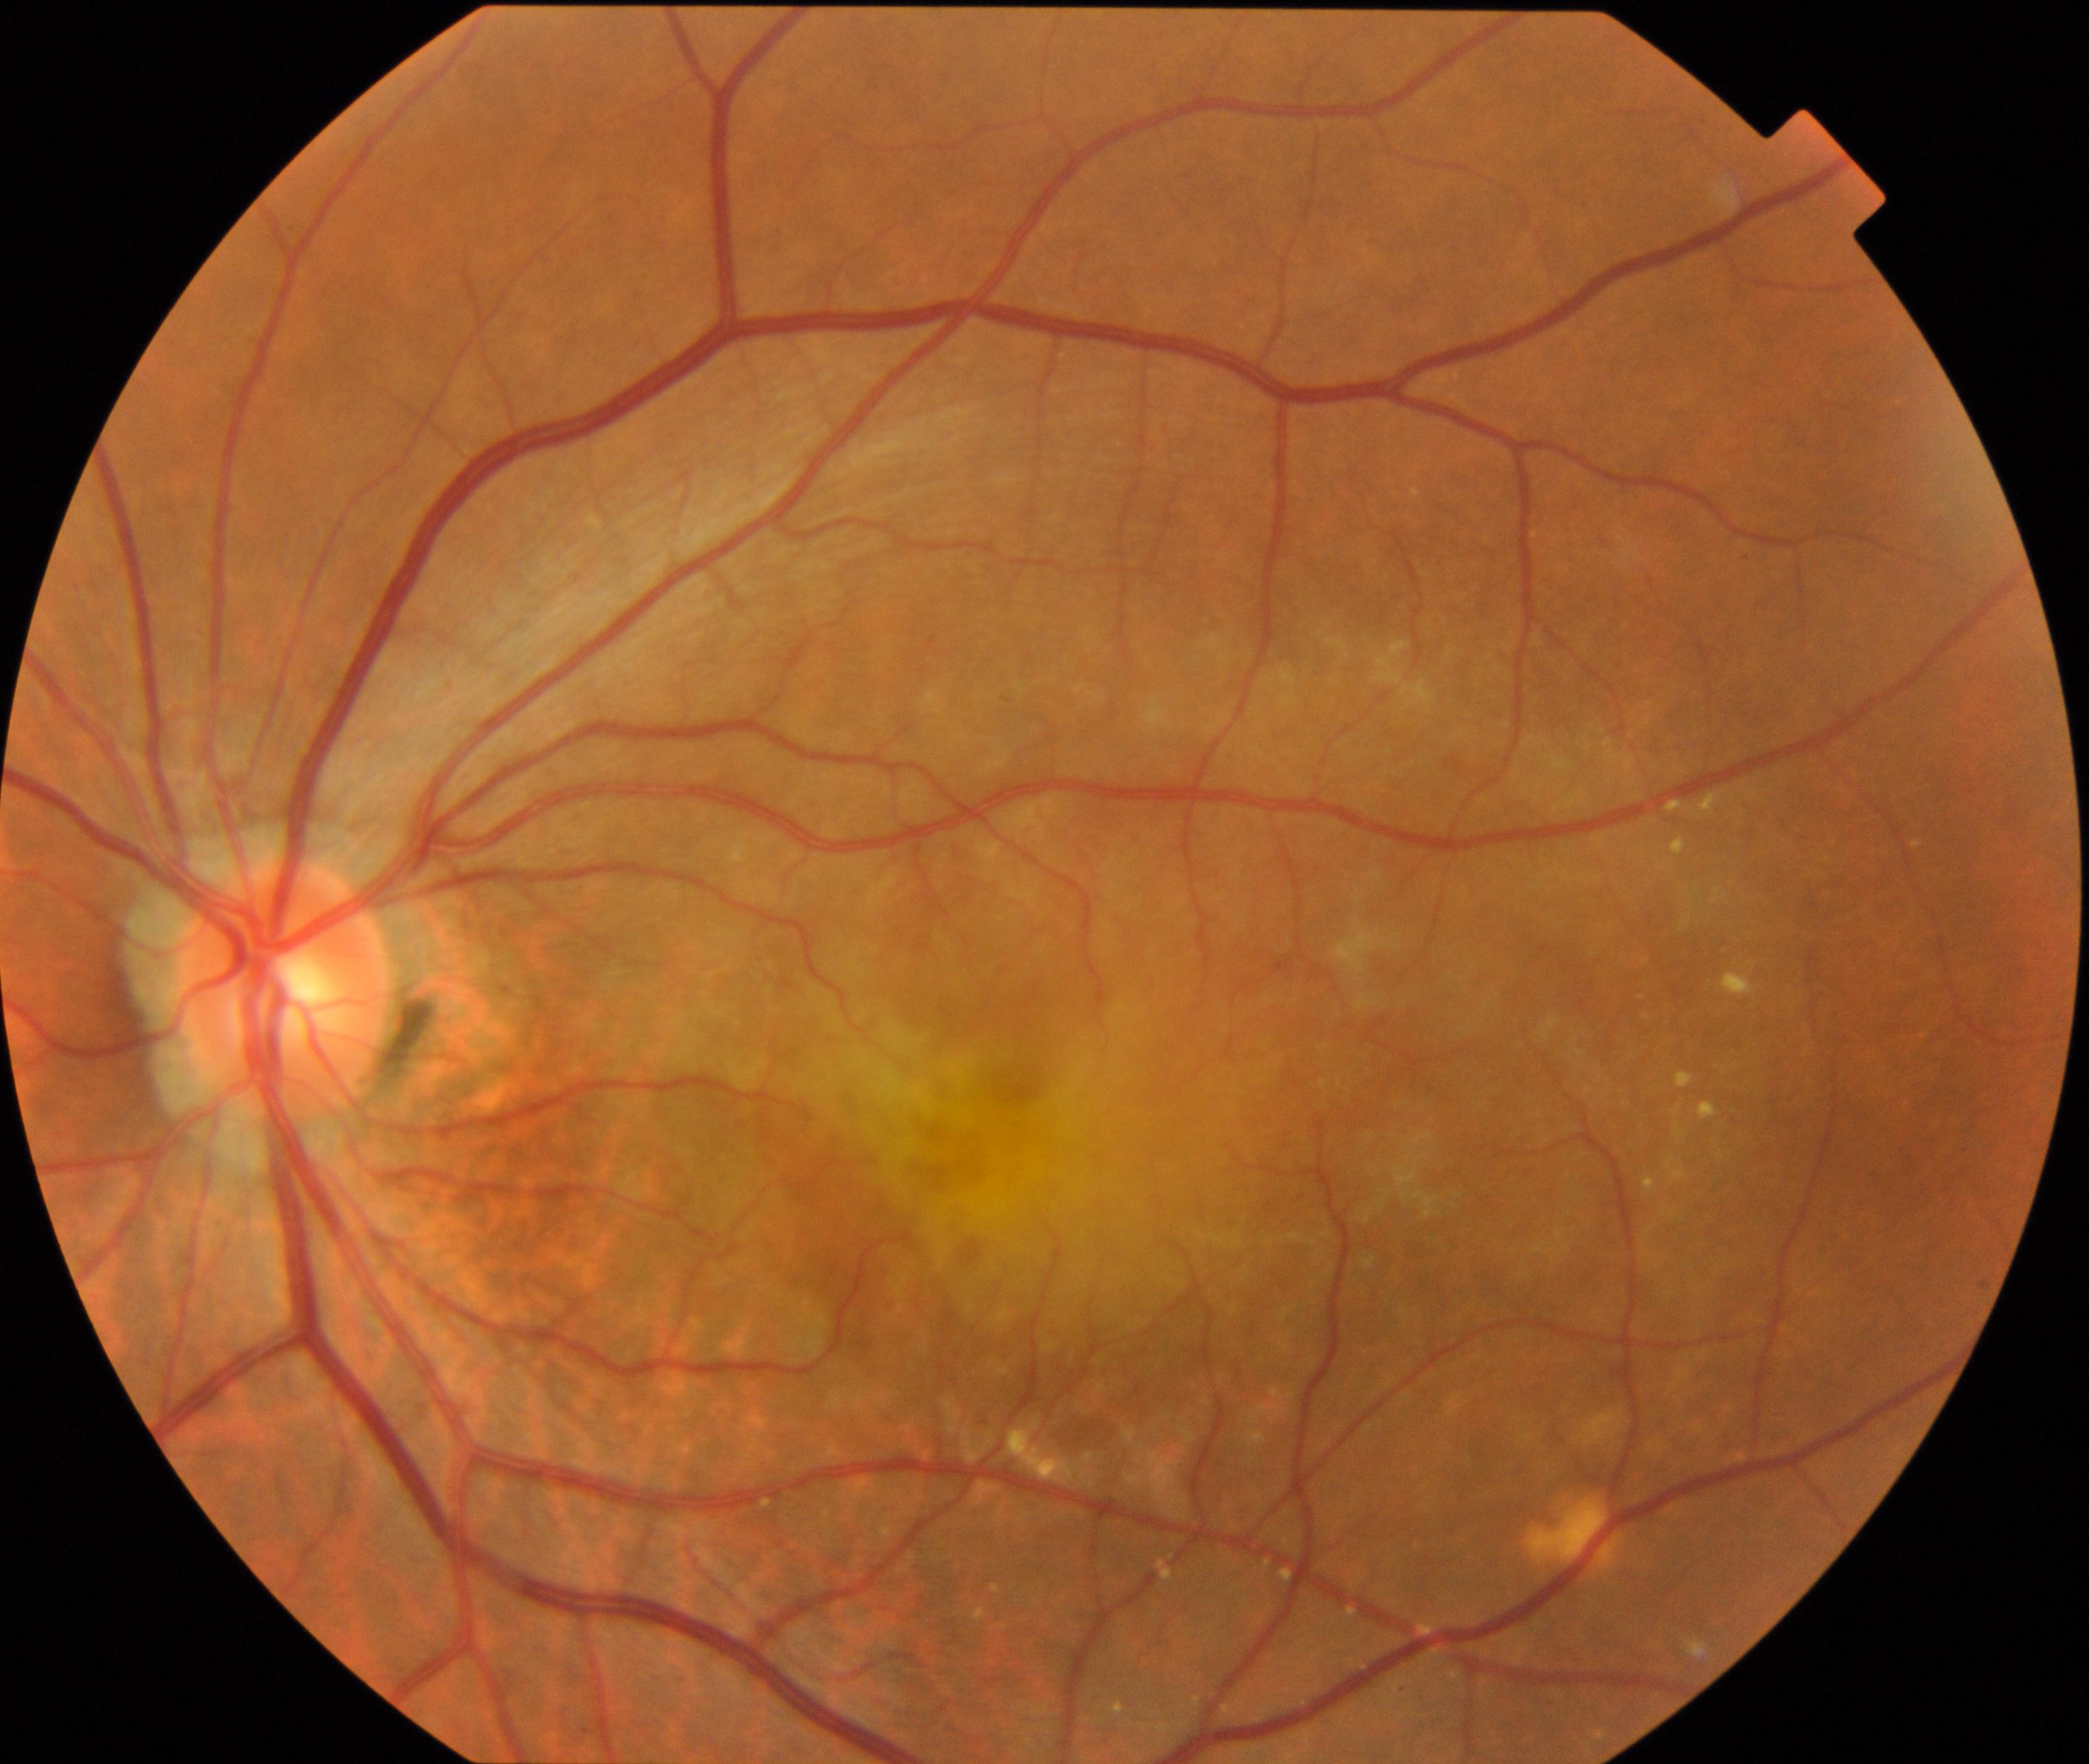
Fundus image consistent with maculopathy.